Image size 1932x1910: 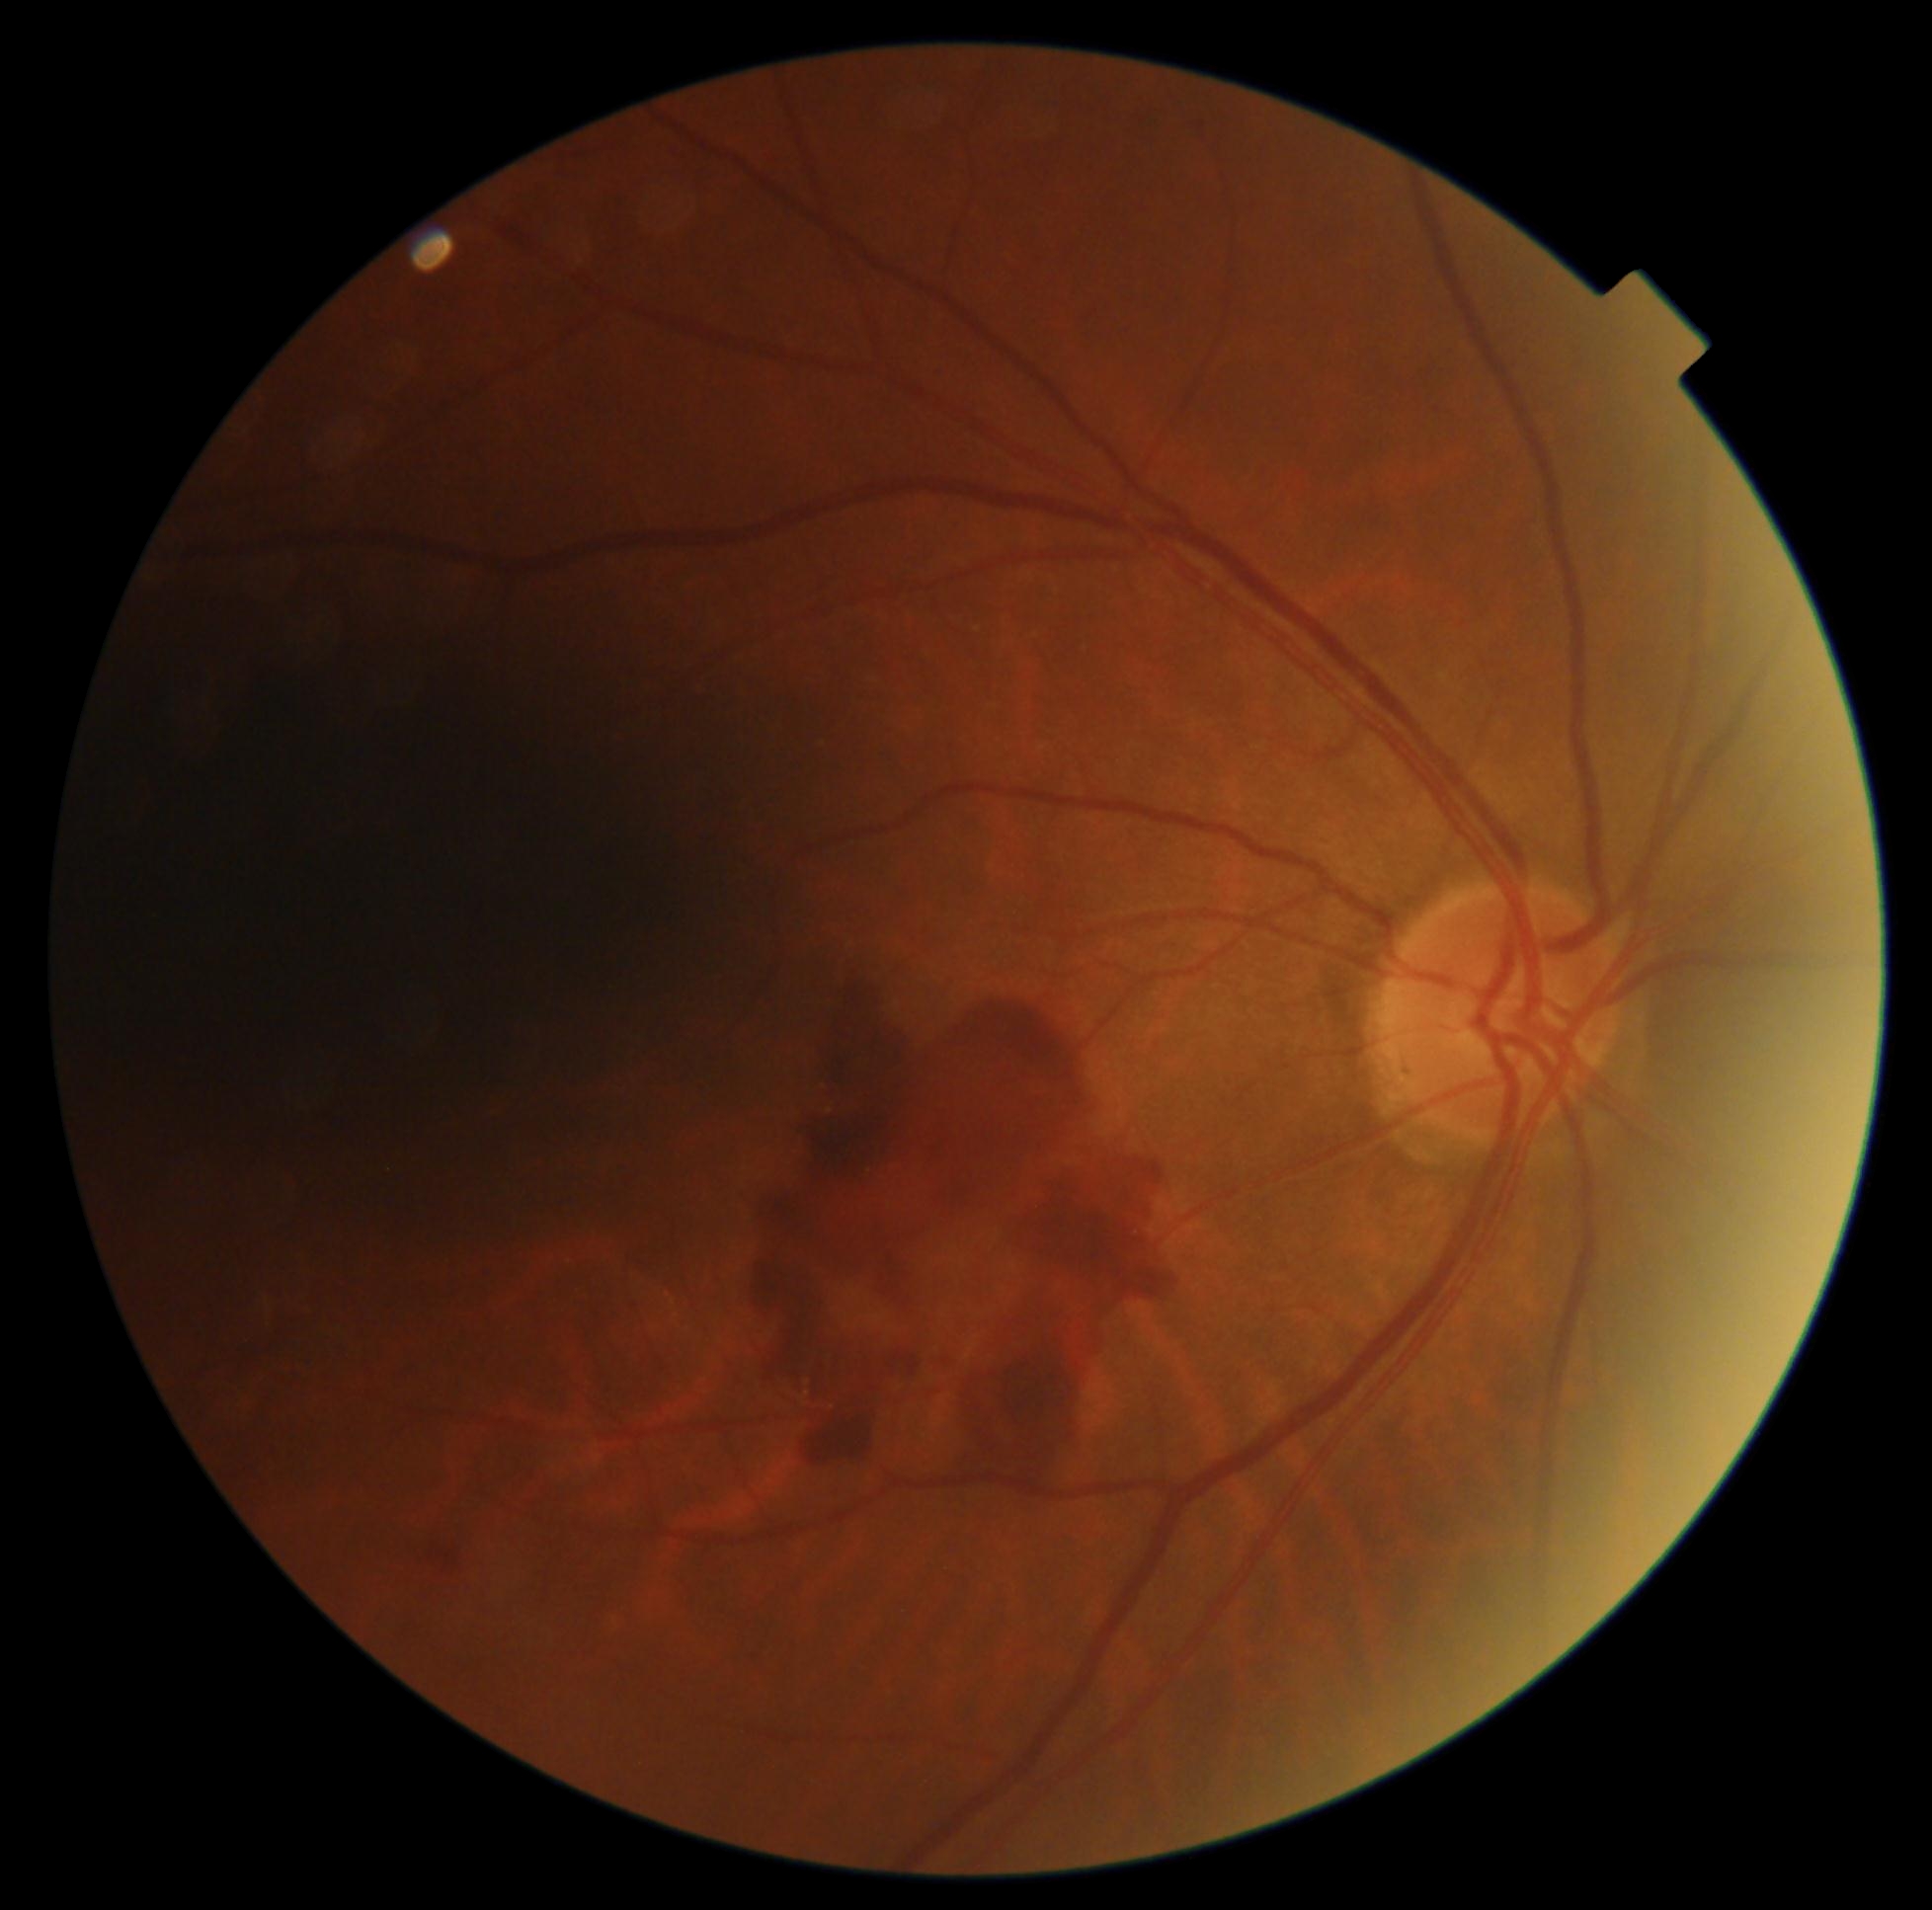 DR stage = PDR (grade 4).